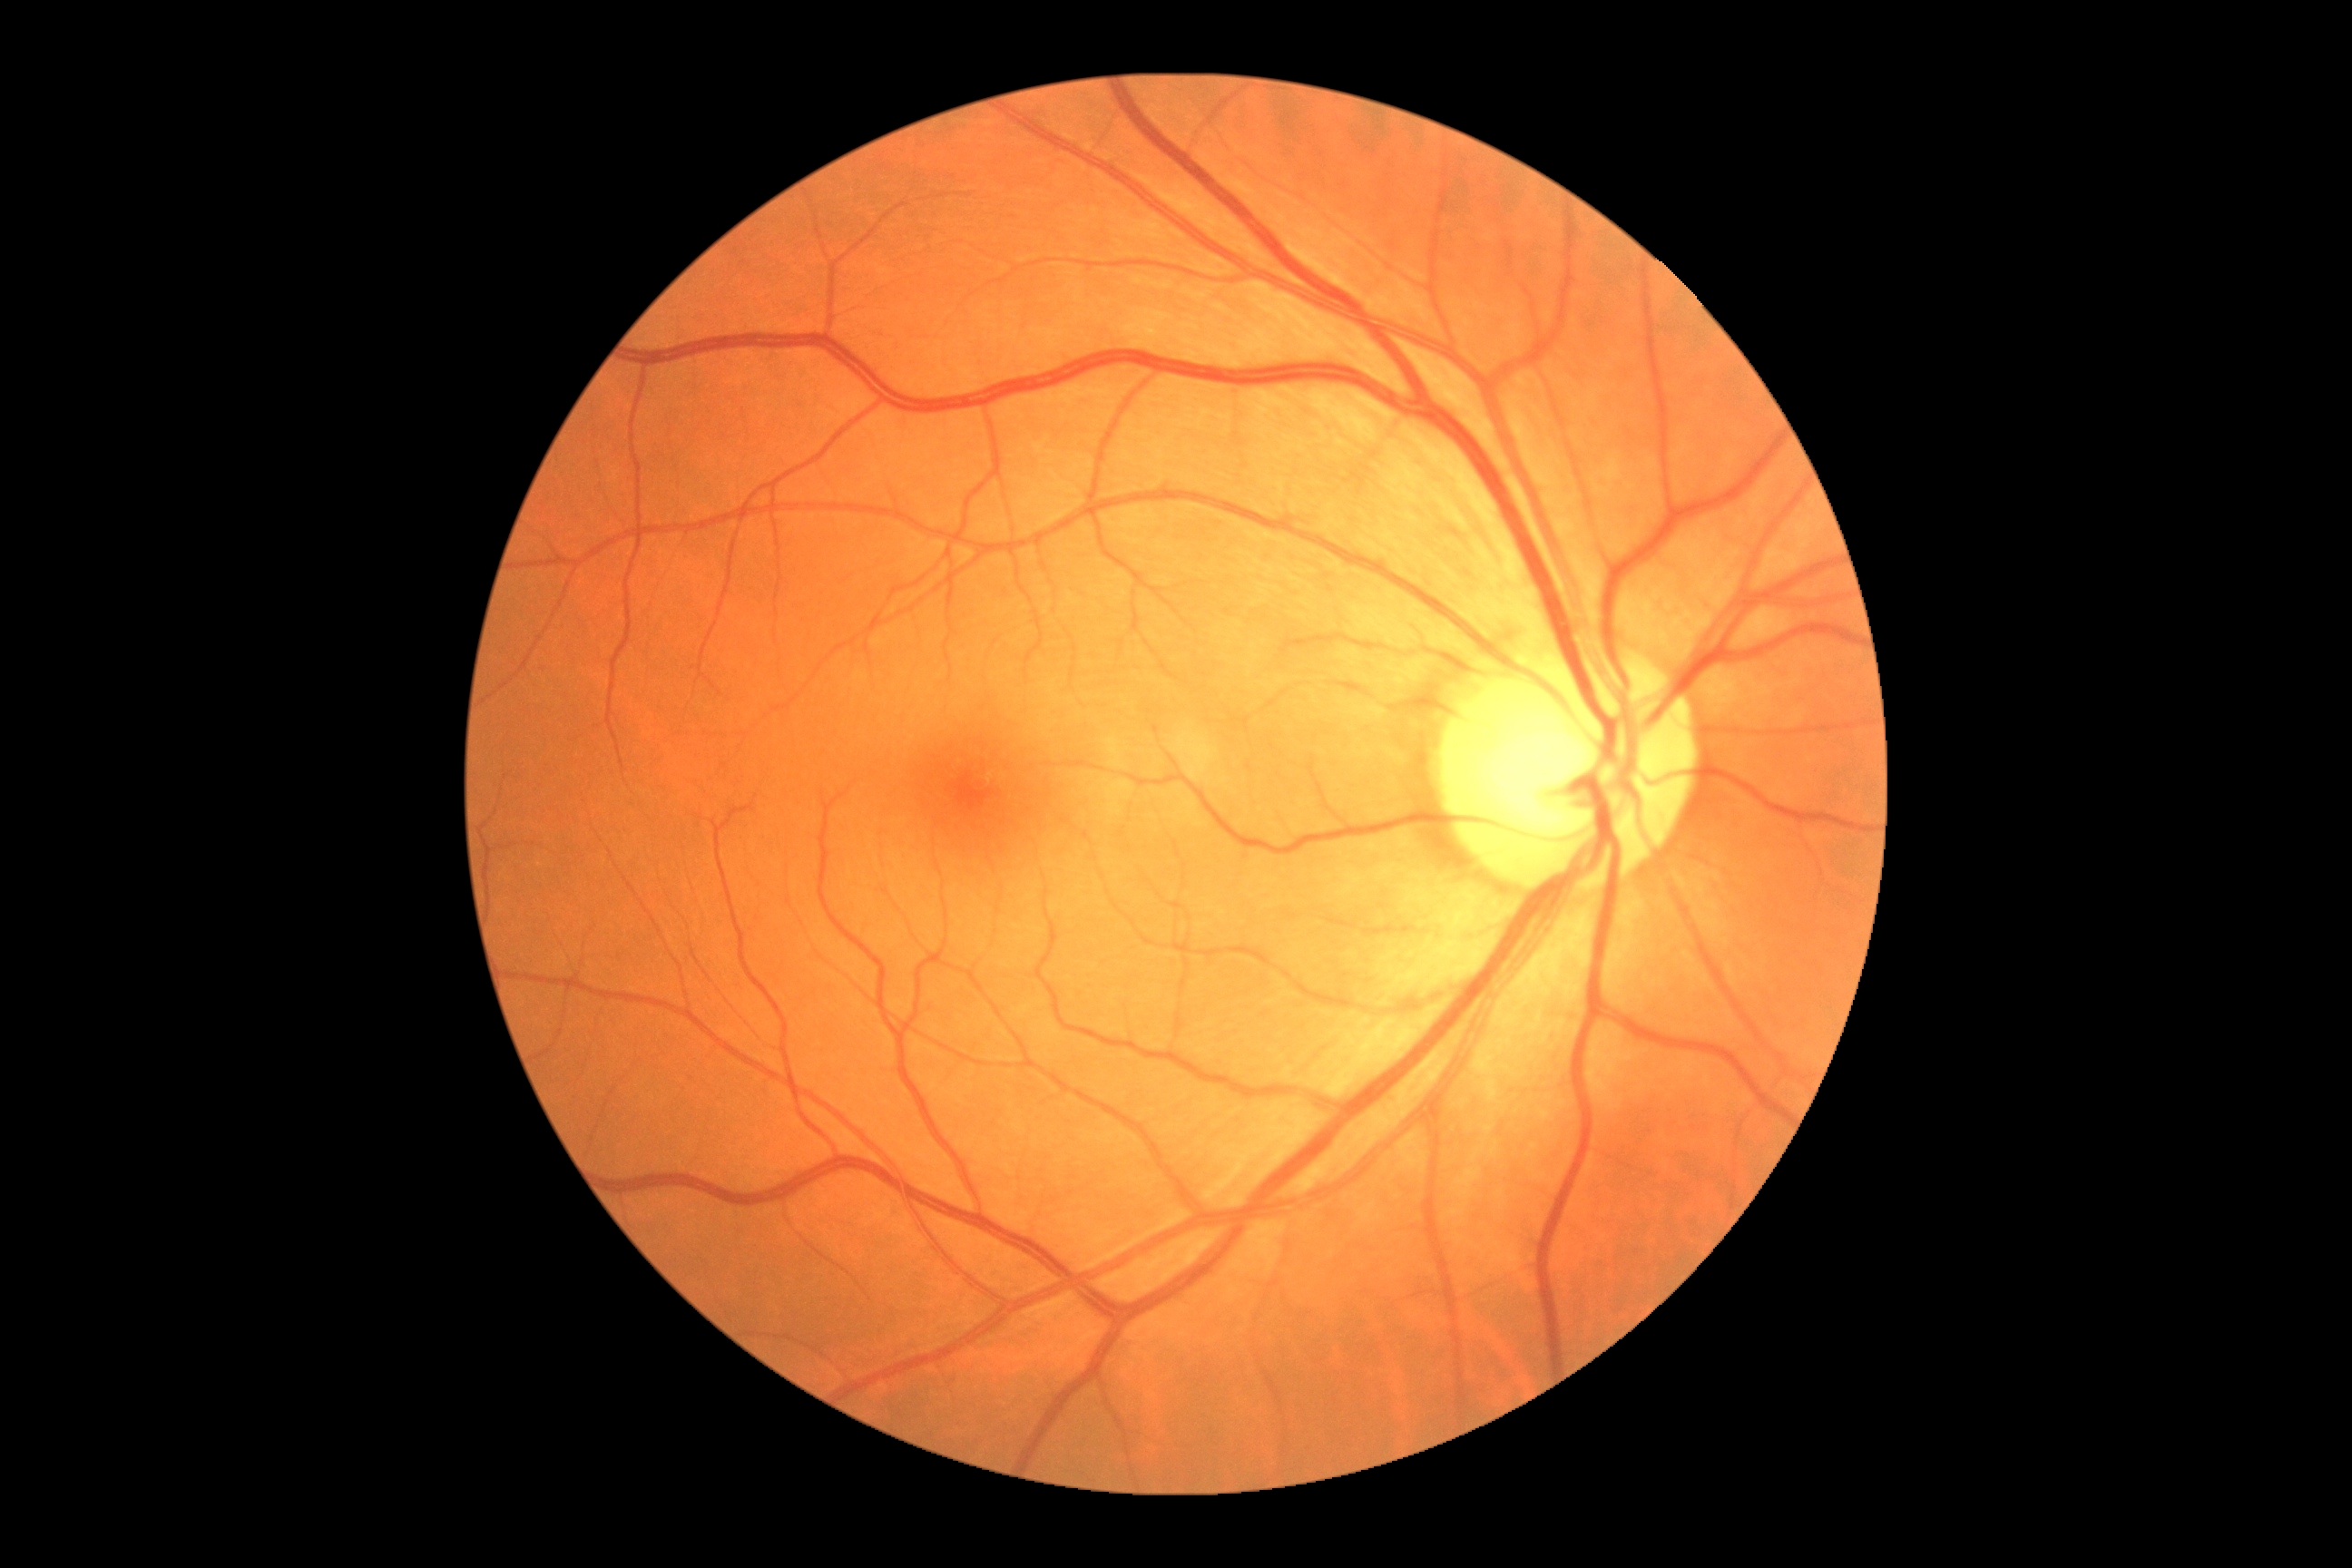 No diabetic retinal disease findings. Diabetic retinopathy (DR): grade 0 (no apparent retinopathy).